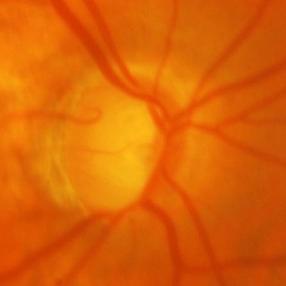

Q: What is the glaucoma diagnosis?
A: Glaucomatous optic neuropathy.